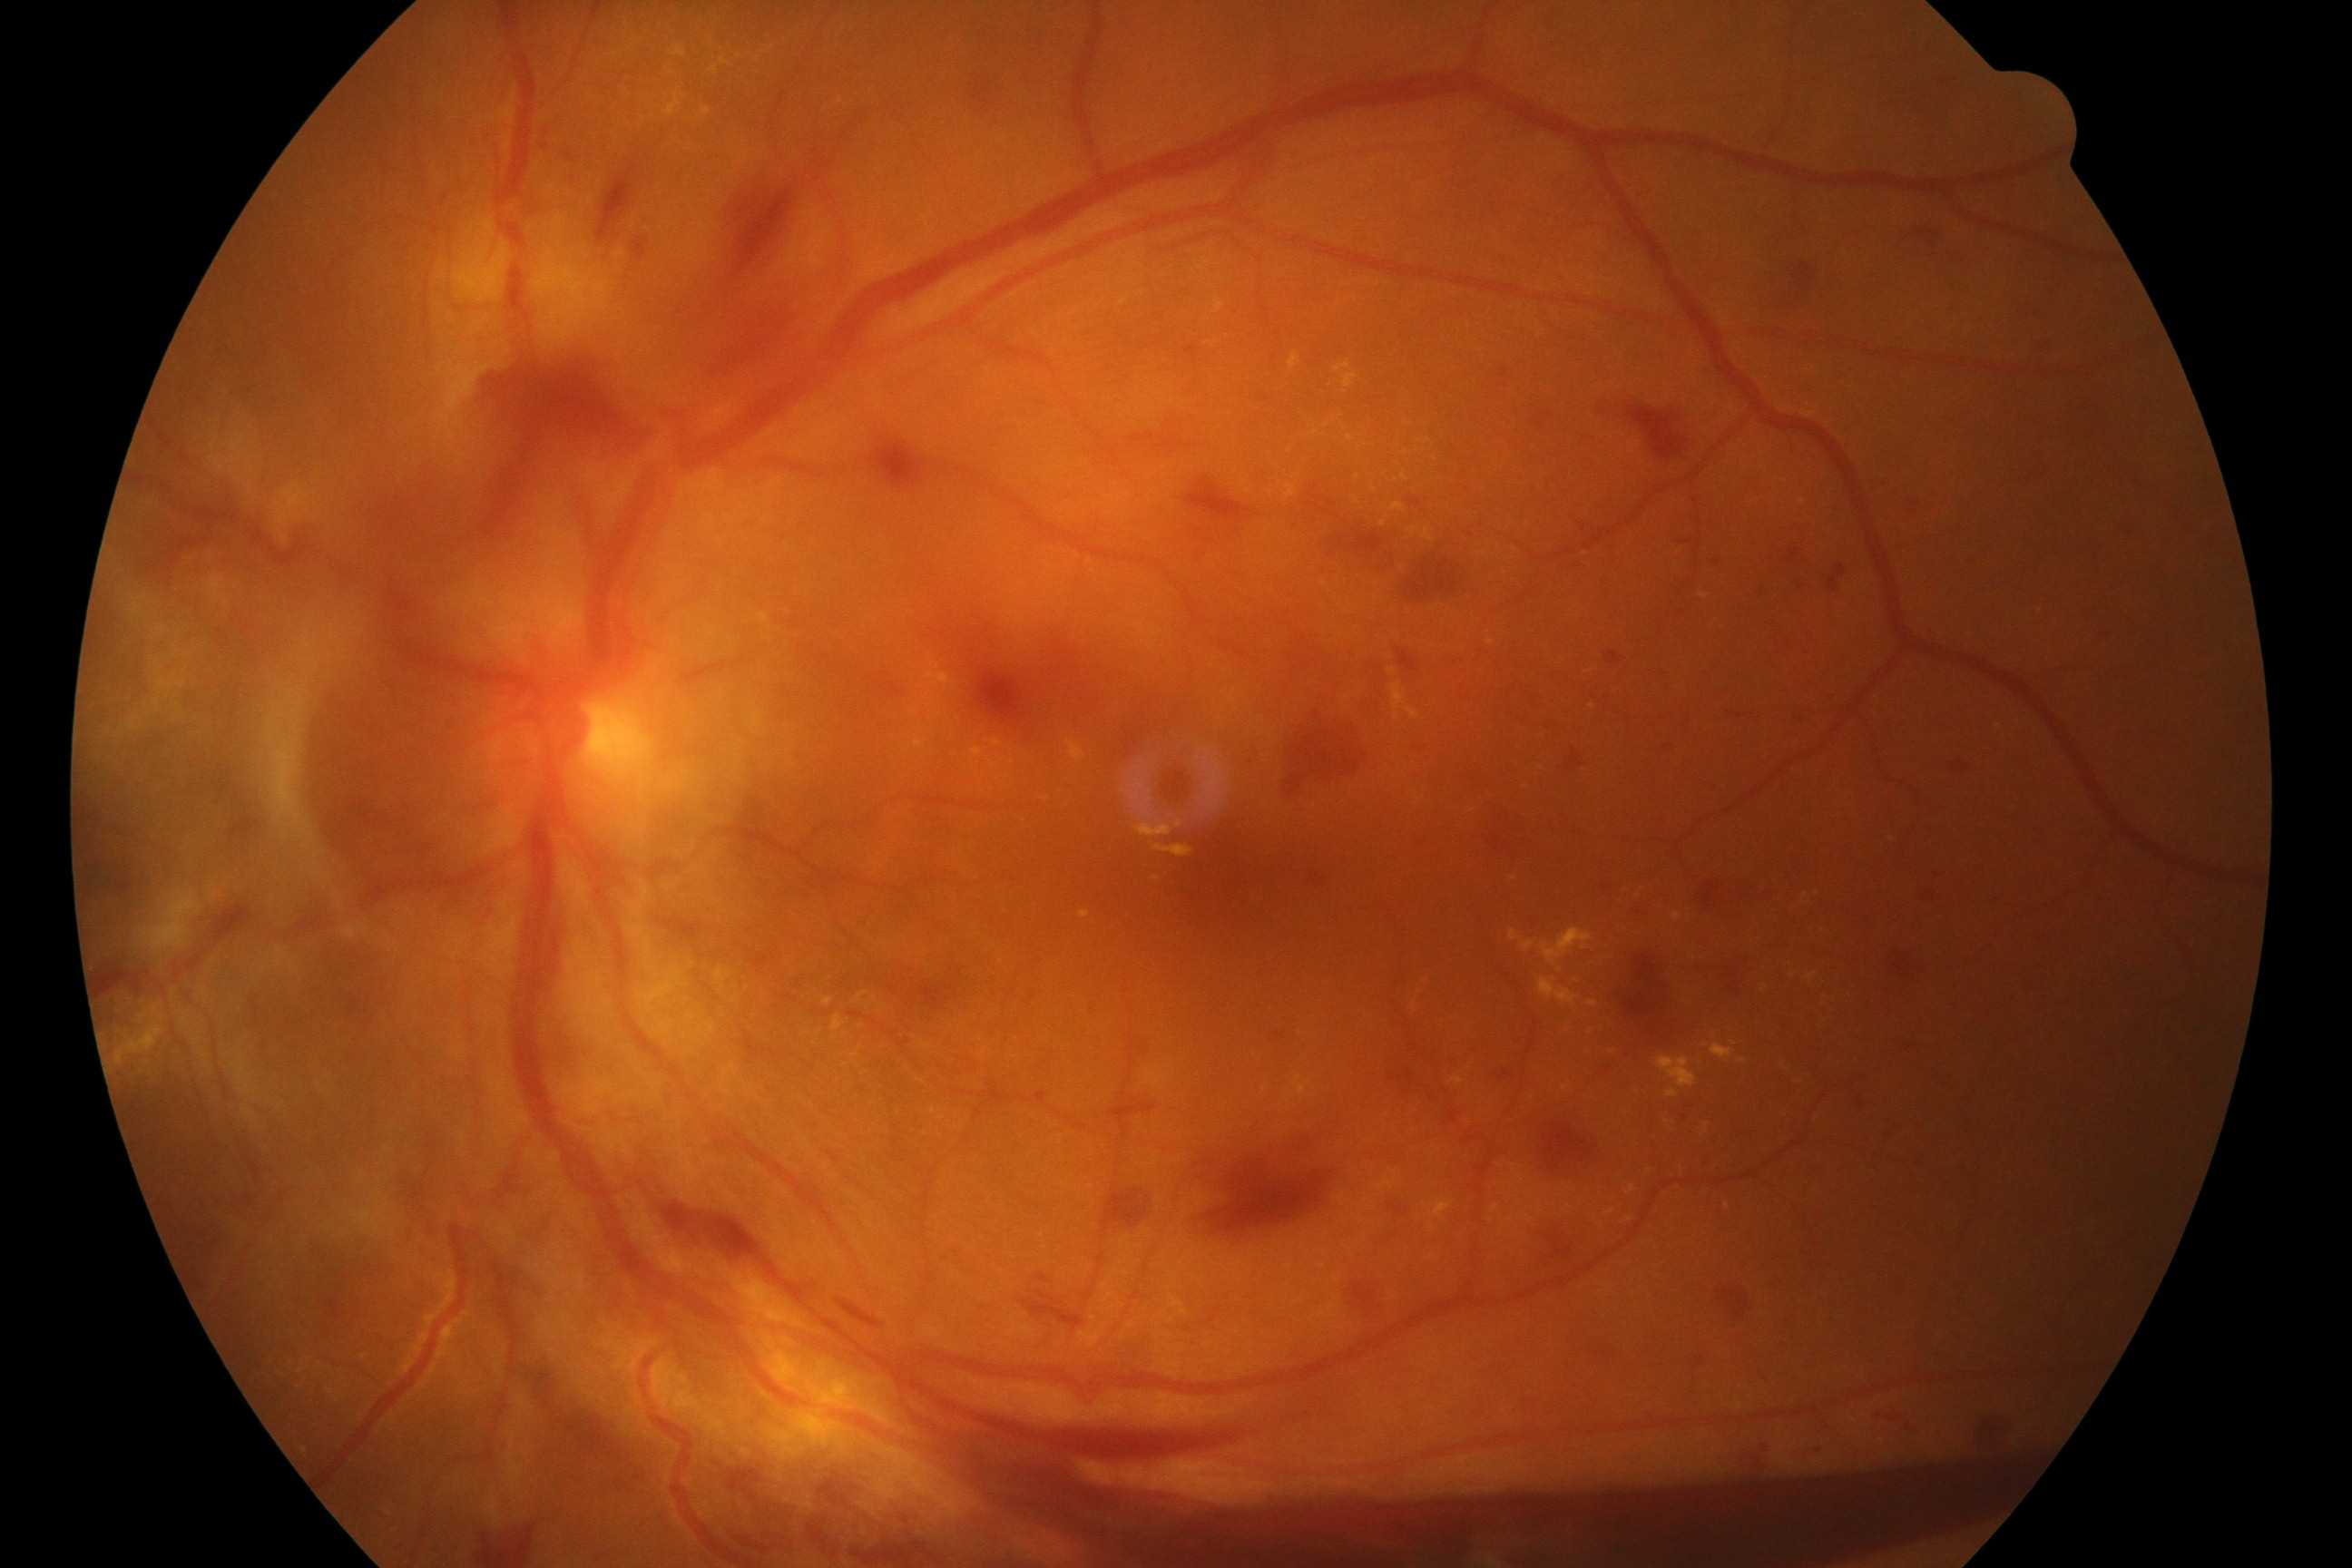
Findings: severe non-proliferative or proliferative diabetic retinopathy.